1240 x 1240 pixels. Phoenix ICON wide-field infant fundus image: 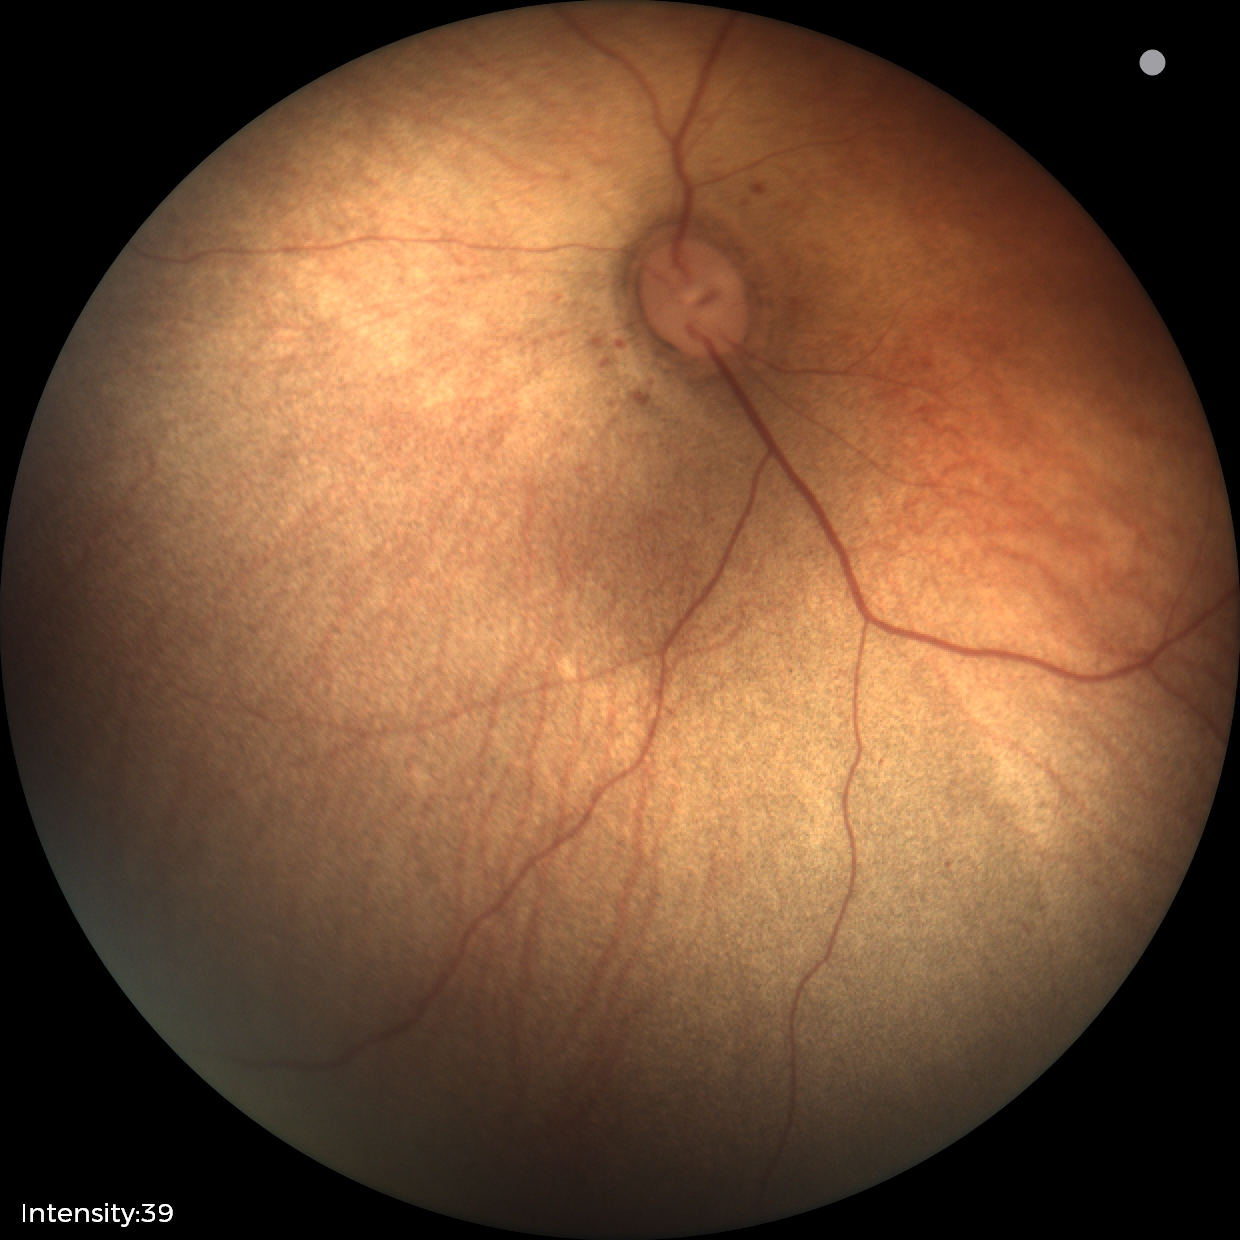 Screening examination with no abnormal retinal findings.